Diabetic retinopathy graded by the modified Davis classification; color fundus image: 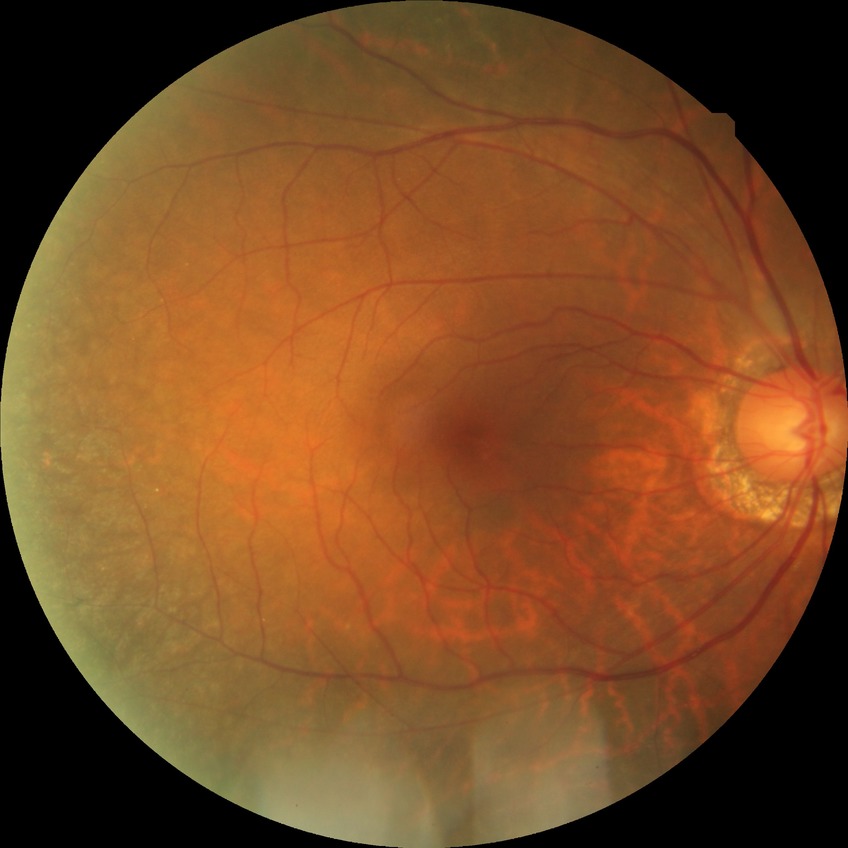 Diabetic retinopathy (DR): NDR (no diabetic retinopathy).